Pediatric wide-field fundus photograph · captured with the Clarity RetCam 3 (130° field of view)
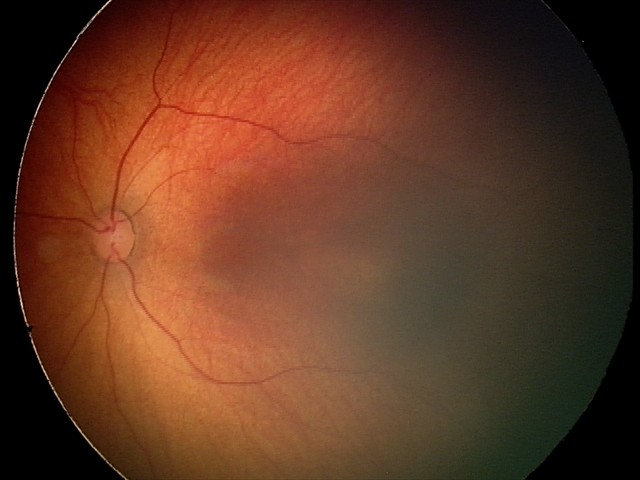 Screening: retinal hemorrhages.